FOV: 45 degrees, retinal fundus photograph, image size 1470x1137: 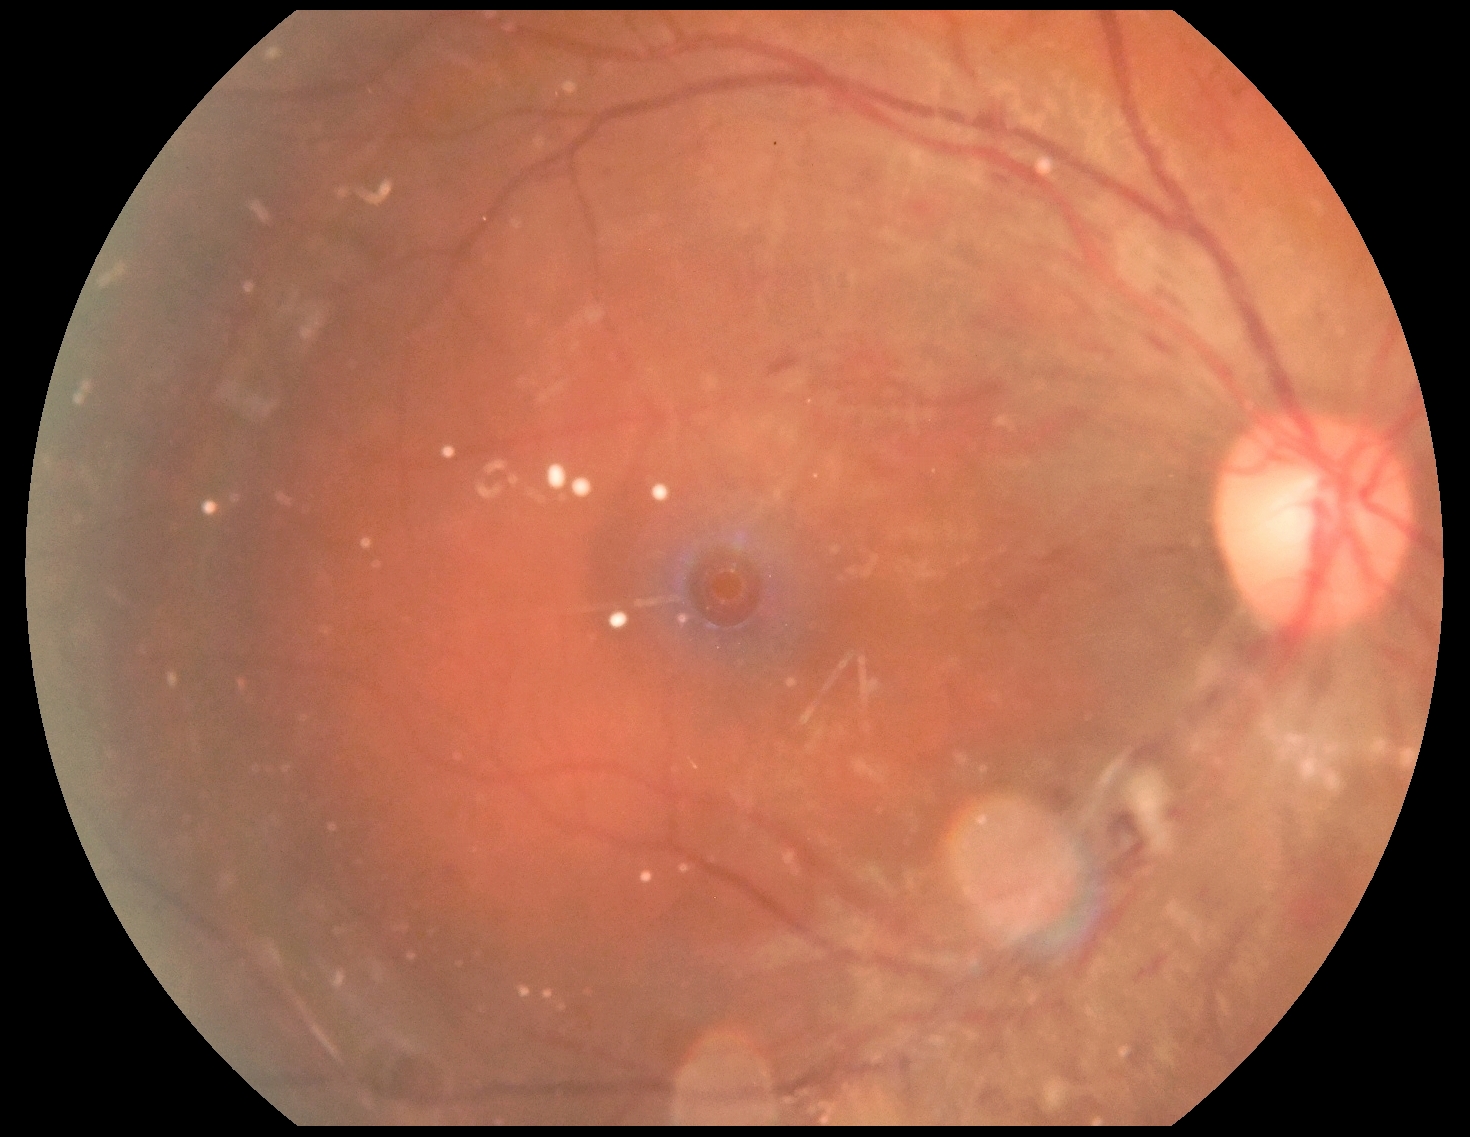

  dr_category: non-proliferative diabetic retinopathy
  dr_grade: moderate non-proliferative diabetic retinopathy (grade 2)